Image size 2048x1536.
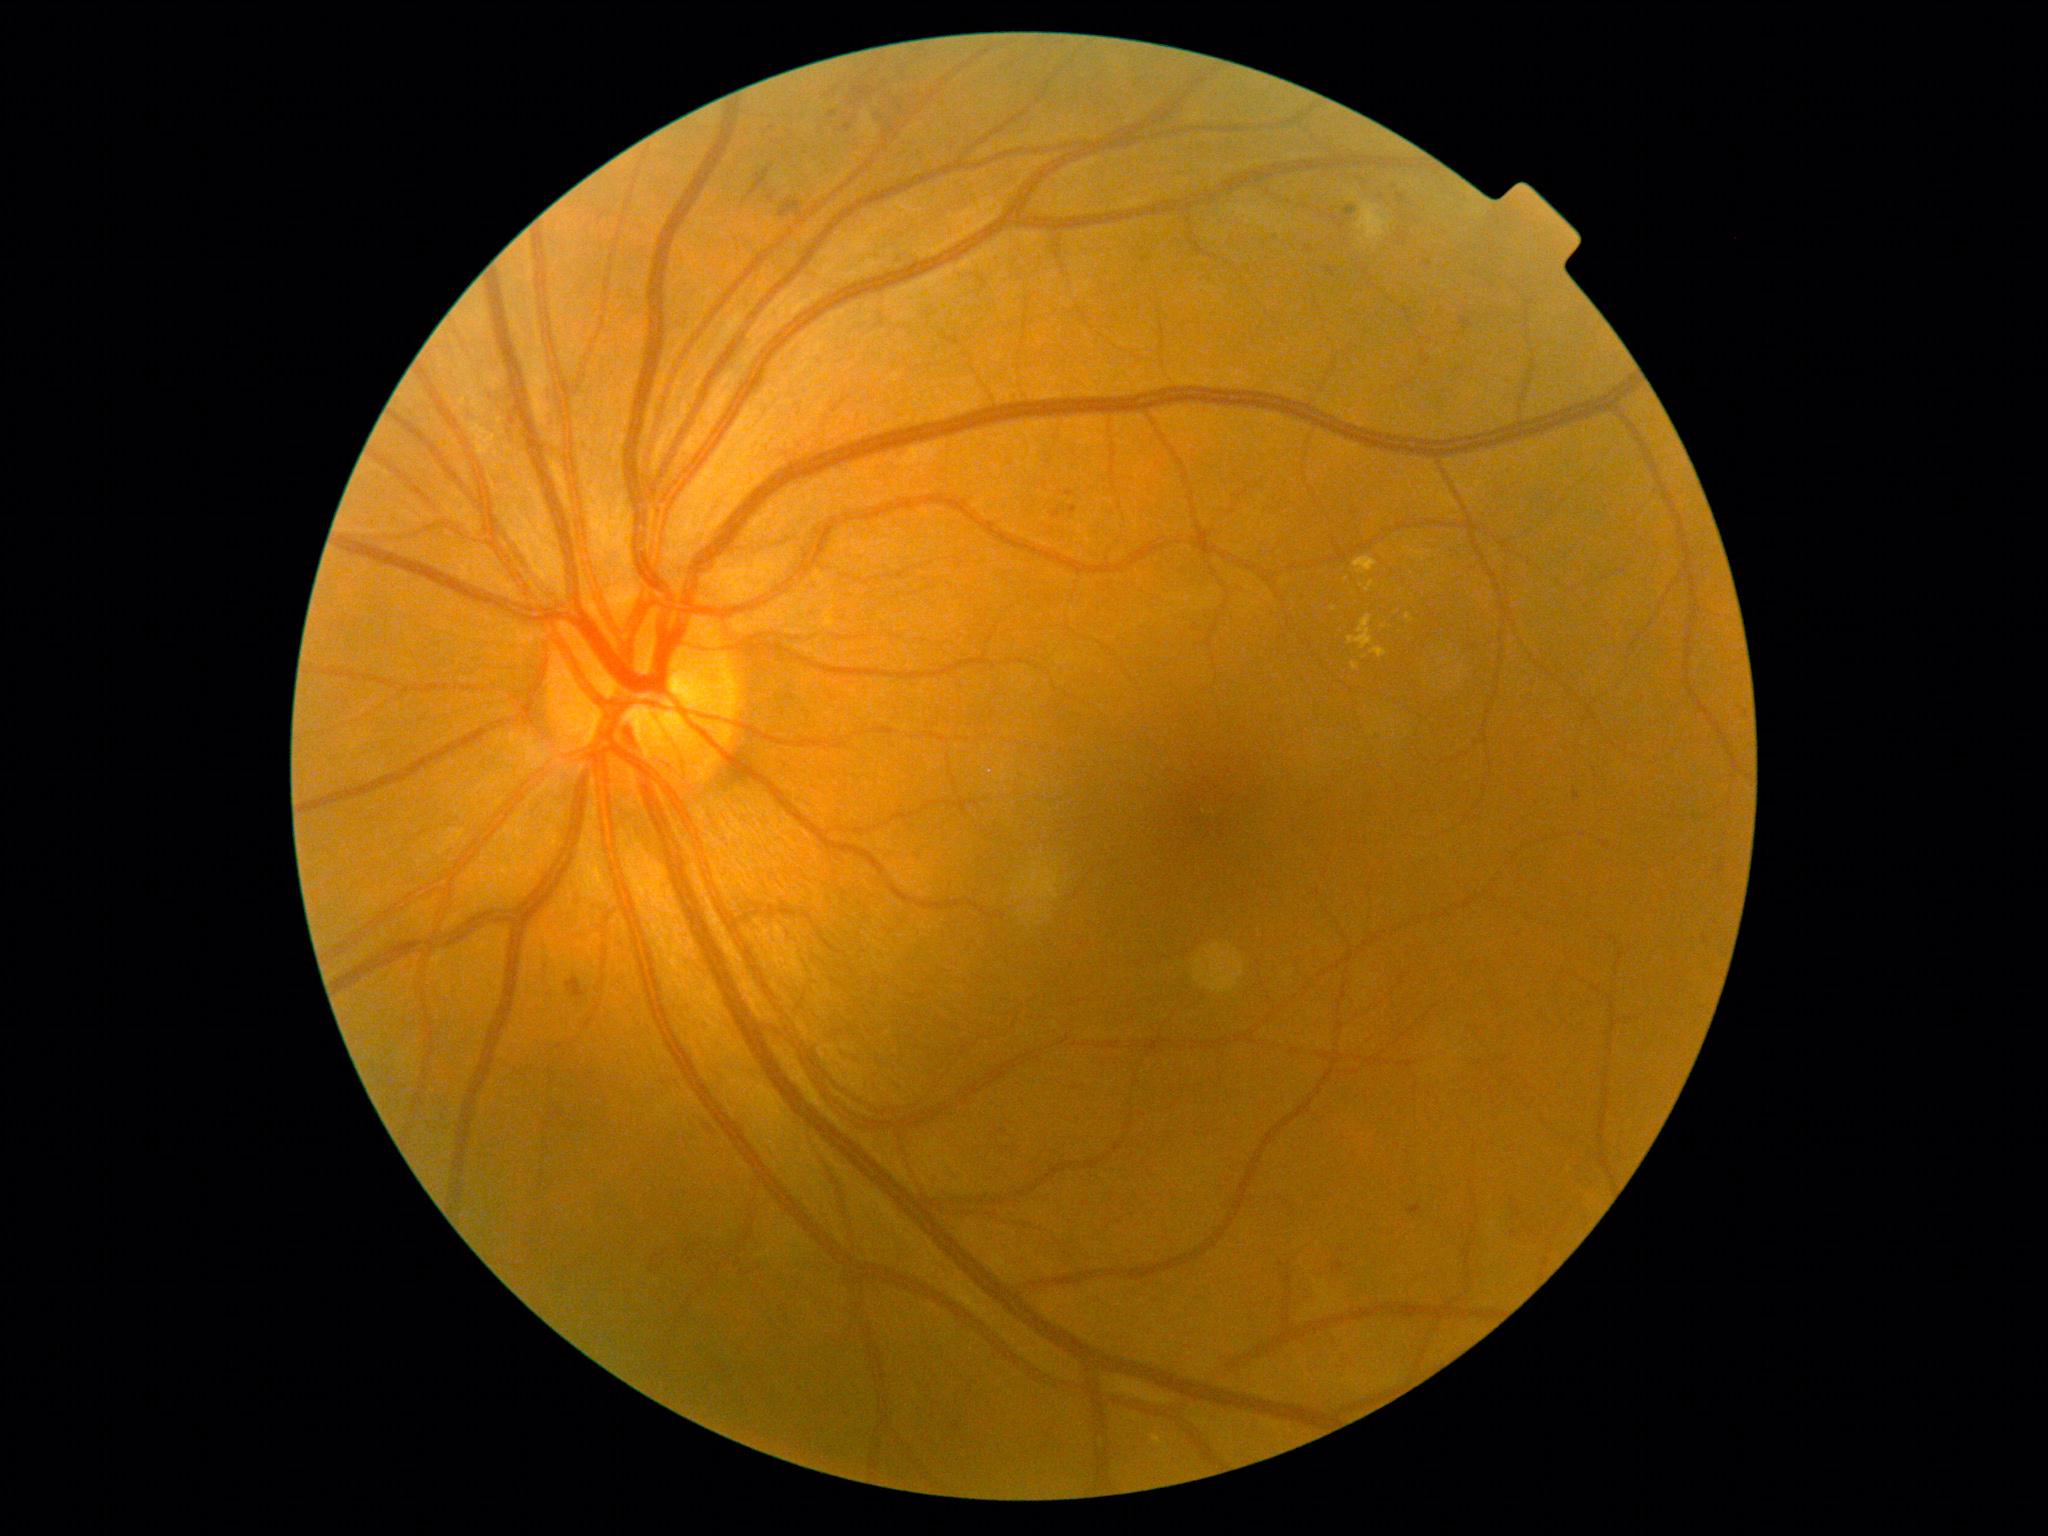 DR severity is grade 2 (moderate NPDR)
Lesions identified (partial list):
- MAs (partial): [x1=1070, y1=506, x2=1077, y2=516]; [x1=1574, y1=789, x2=1582, y2=801]; [x1=1516, y1=1209, x2=1523, y2=1219]; [x1=829, y1=112, x2=837, y2=119]; [x1=1397, y1=194, x2=1404, y2=202]; [x1=1344, y1=207, x2=1357, y2=217]; [x1=1407, y1=1206, x2=1423, y2=1215]; [x1=1327, y1=268, x2=1335, y2=277]; [x1=843, y1=125, x2=852, y2=133]
- Small MAs near 561/1047